Pediatric retinal photograph (wide-field): 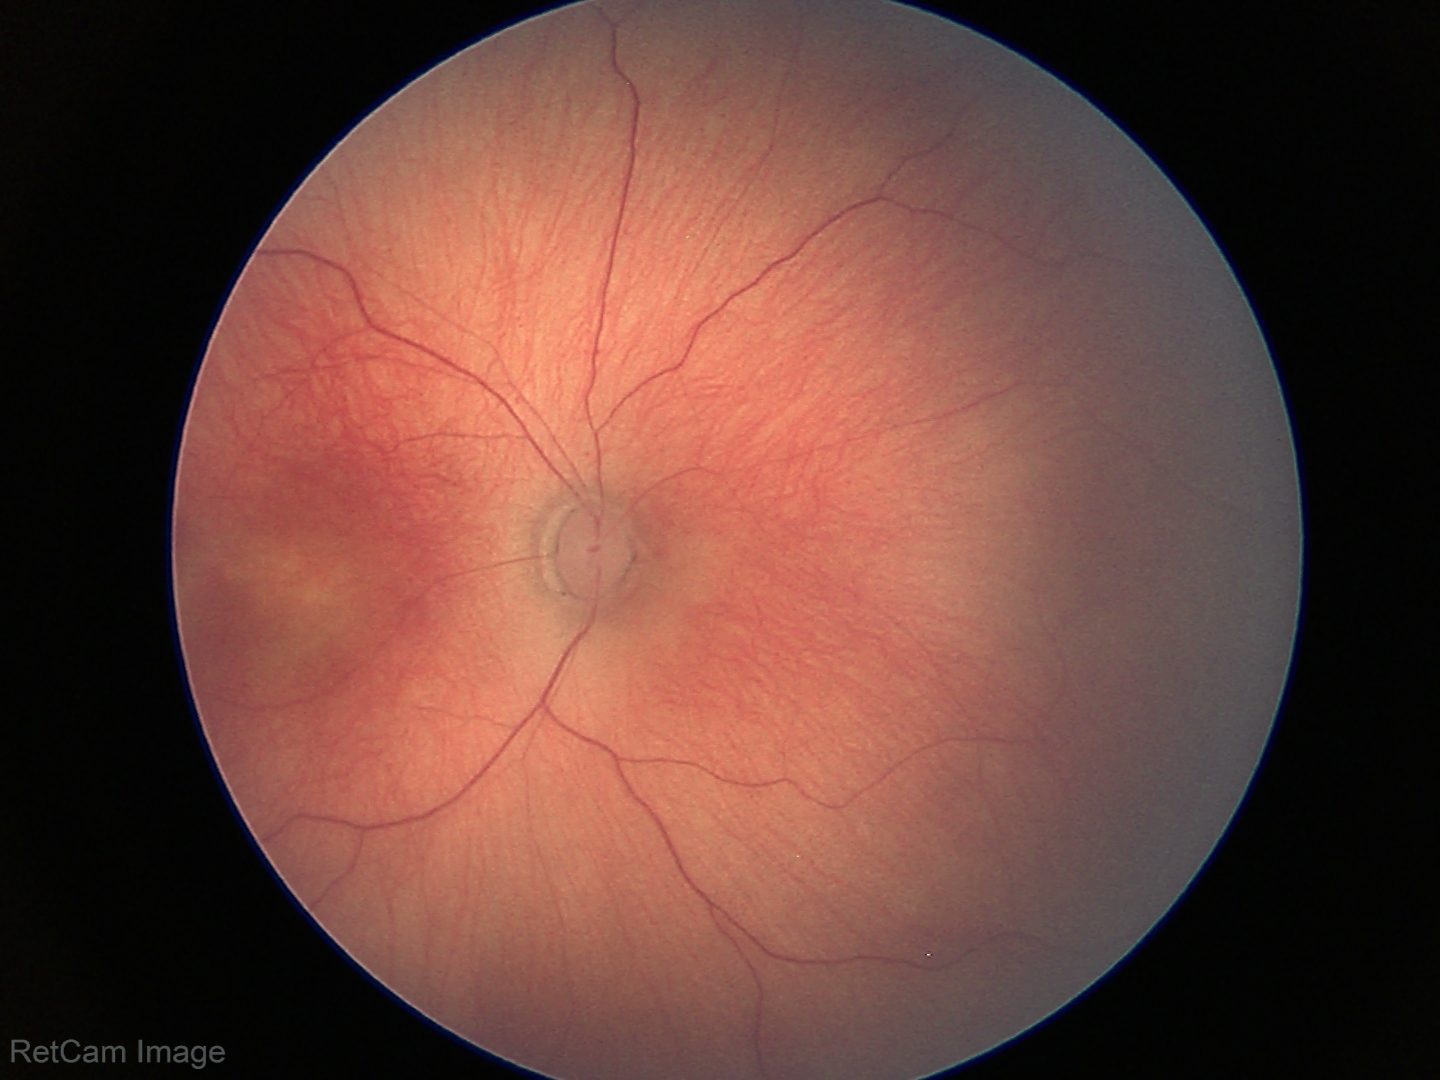 Q: What is the plus-form classification?
A: no plus disease
Q: What was the screening finding?
A: status post retinopathy of prematurity (ROP) — retinal appearance after treated retinopathy of prematurity